Retinal fundus photograph — 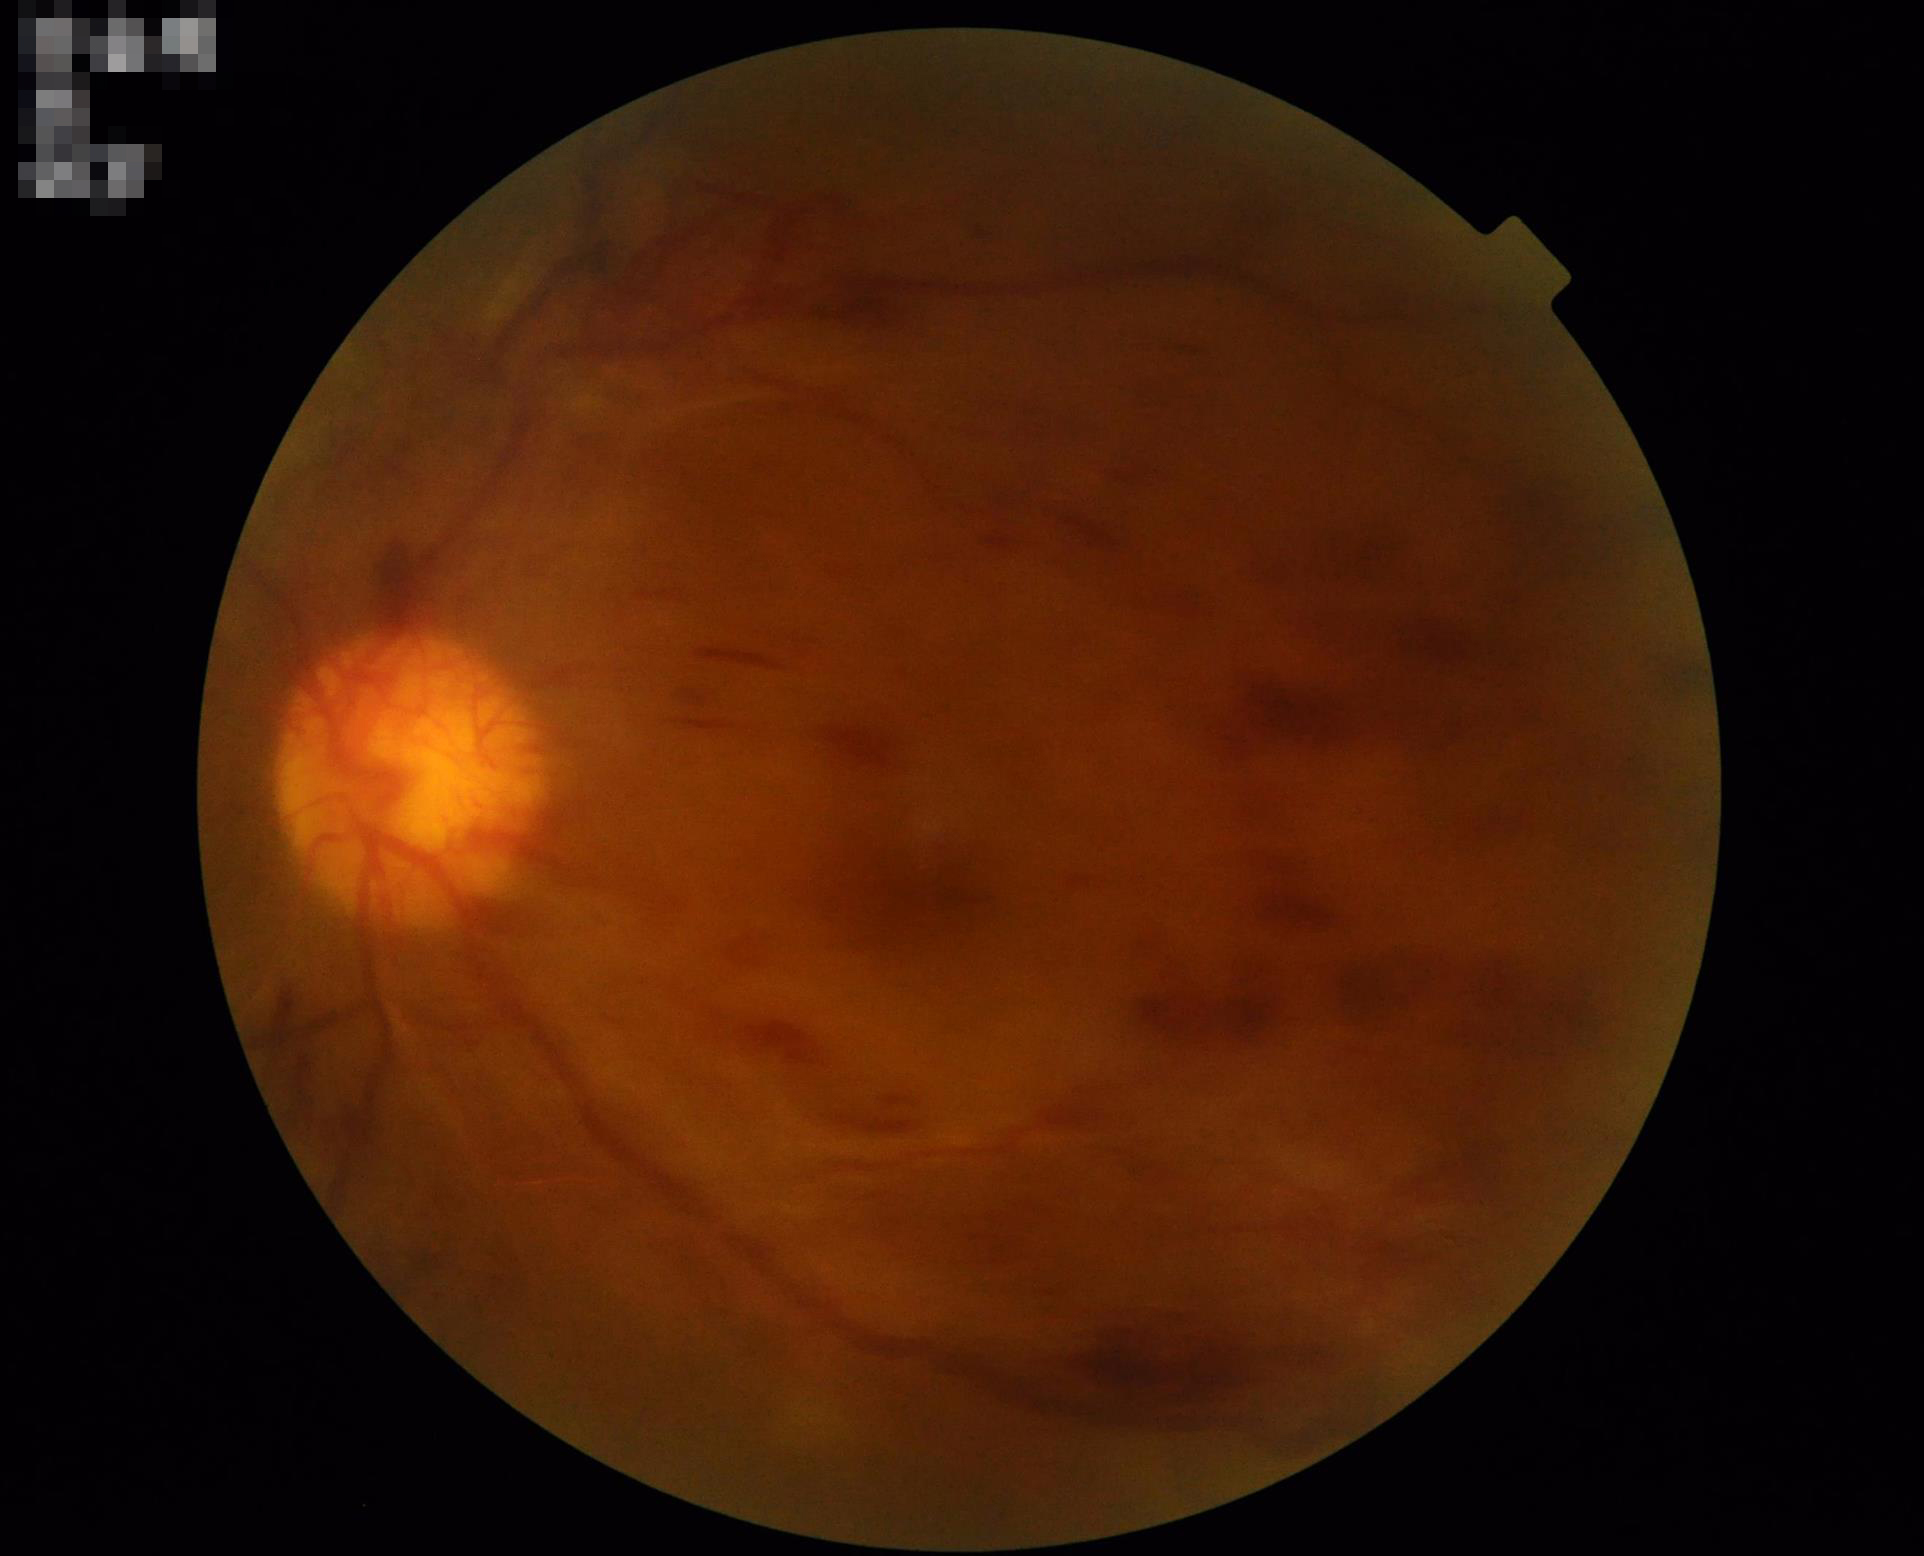 Quality grading:
- overall: poor, ungradable
- sharpness: reduced sharpness with visible blur
- illumination: uniform, no color cast
- contrast: narrow intensity range, structures hard to distinguish